No pharmacologic dilation · posterior pole photograph · 45° field of view · NIDEK AFC-230 — 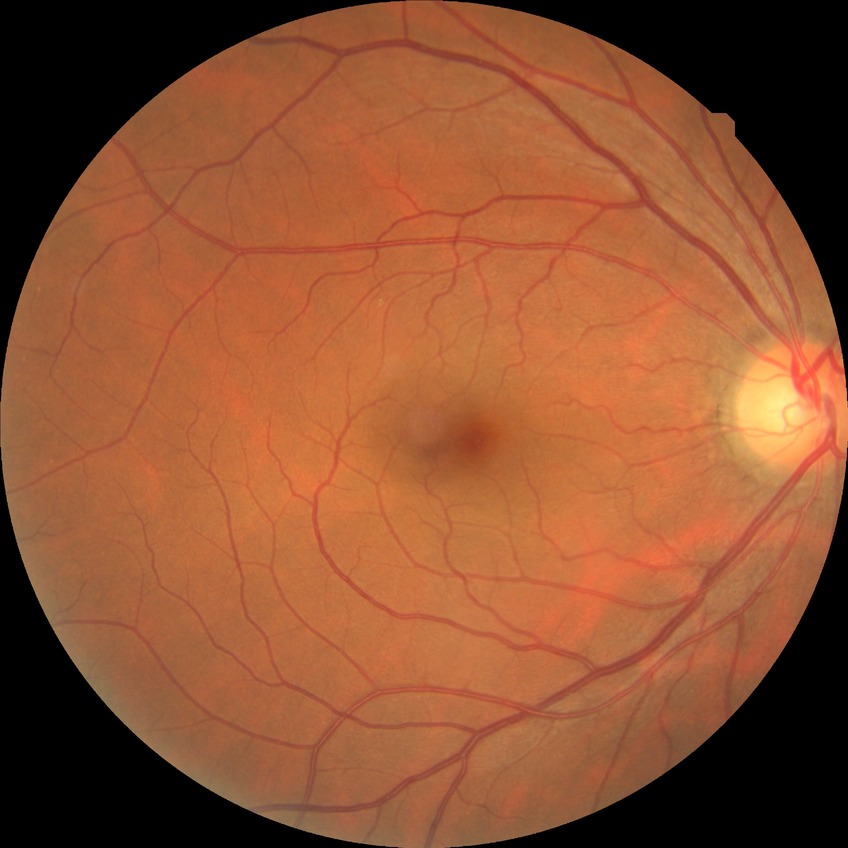 {
  "davis_grade": "no diabetic retinopathy (NDR)"
}